Retinal fundus photograph, 45° field of view: 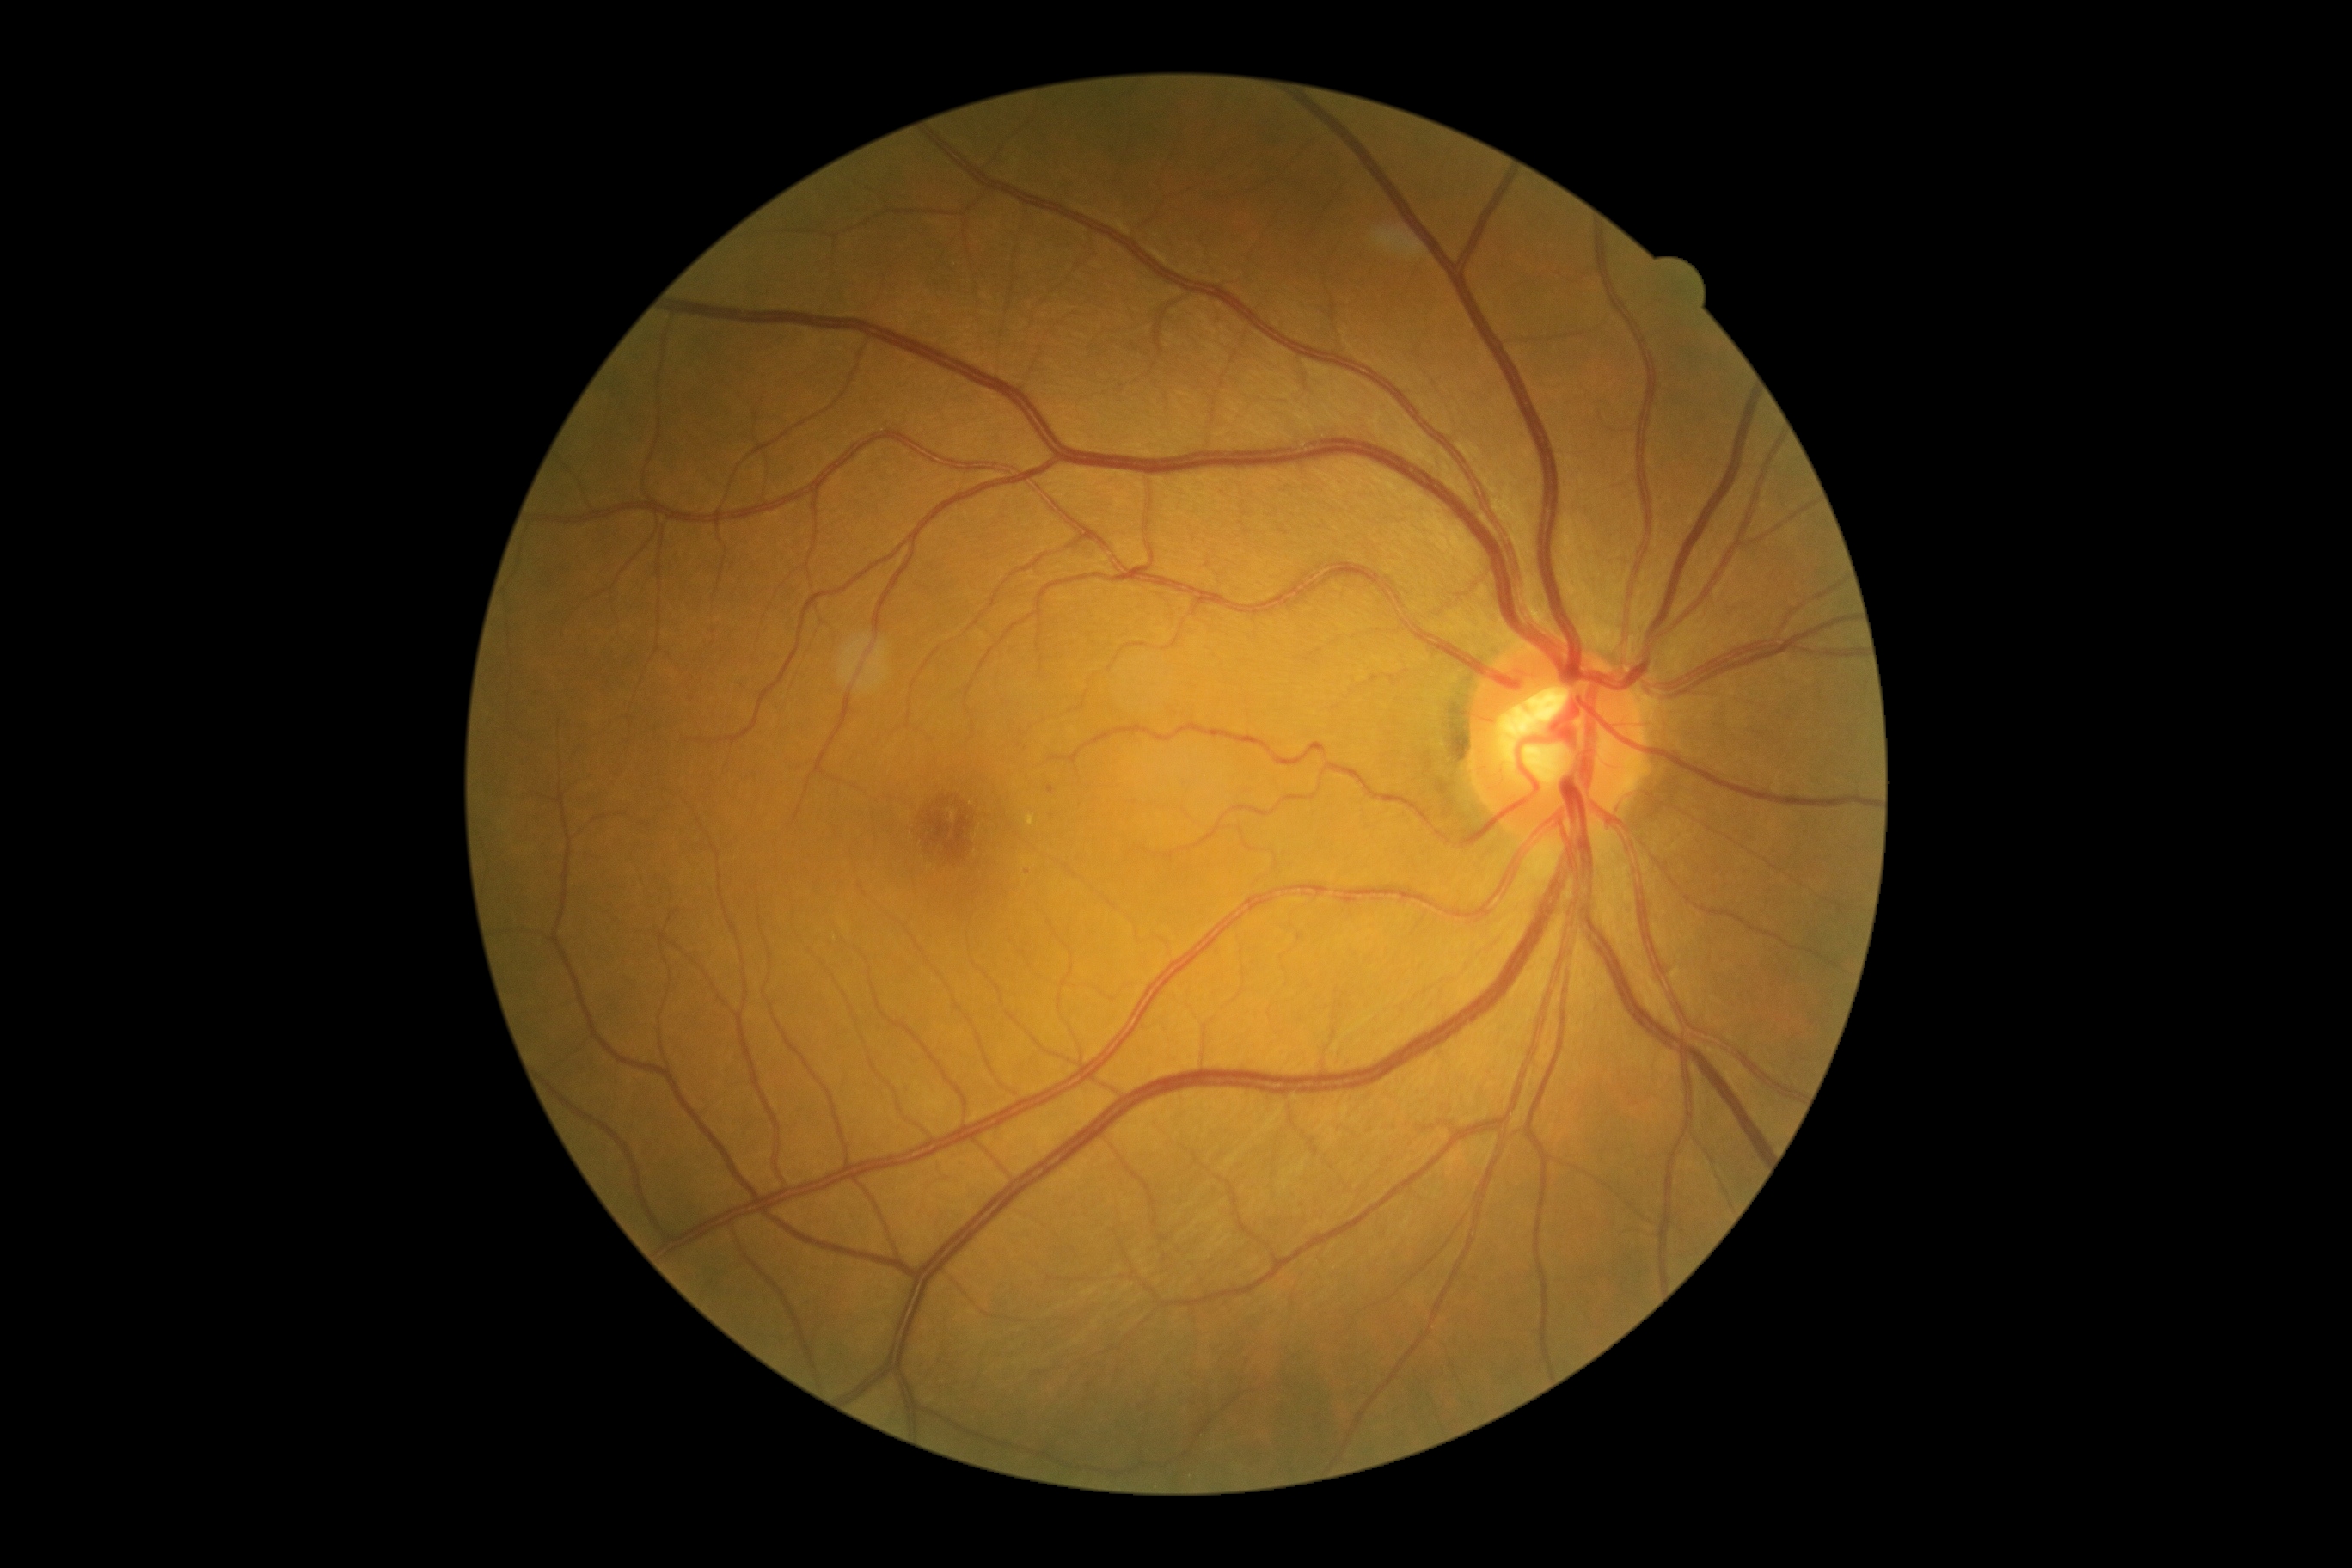 Disease class: non-proliferative diabetic retinopathy. DR severity: 1/4.